Nonmydriatic; NIDEK AFC-230
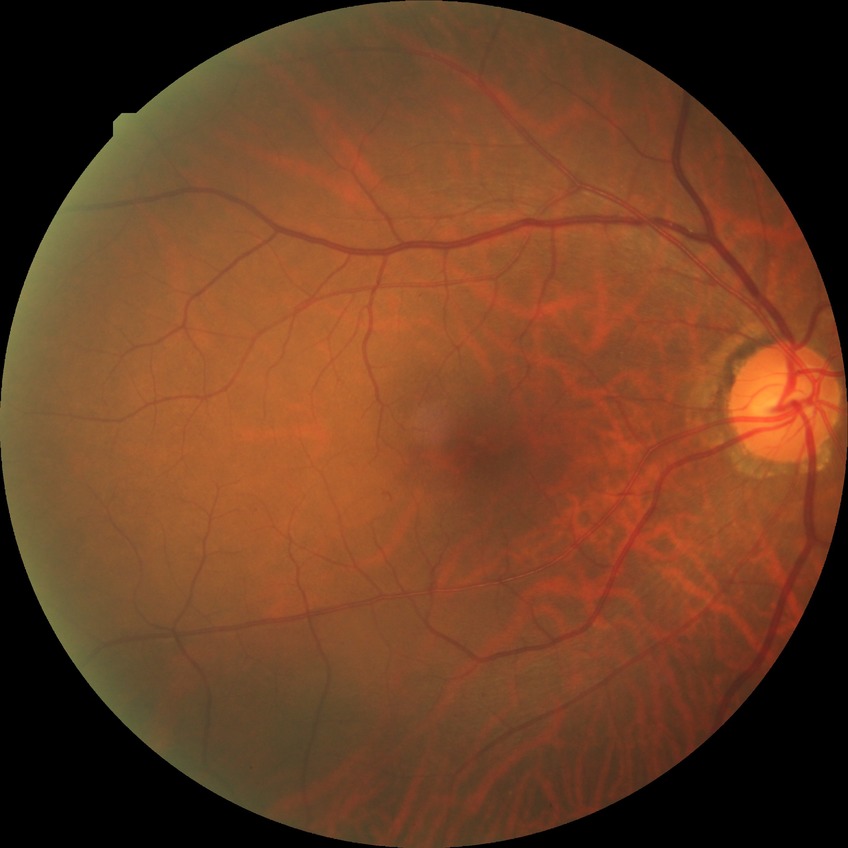 {"davis_grade": "no diabetic retinopathy"}